Phoenix ICON wide-field infant fundus image:
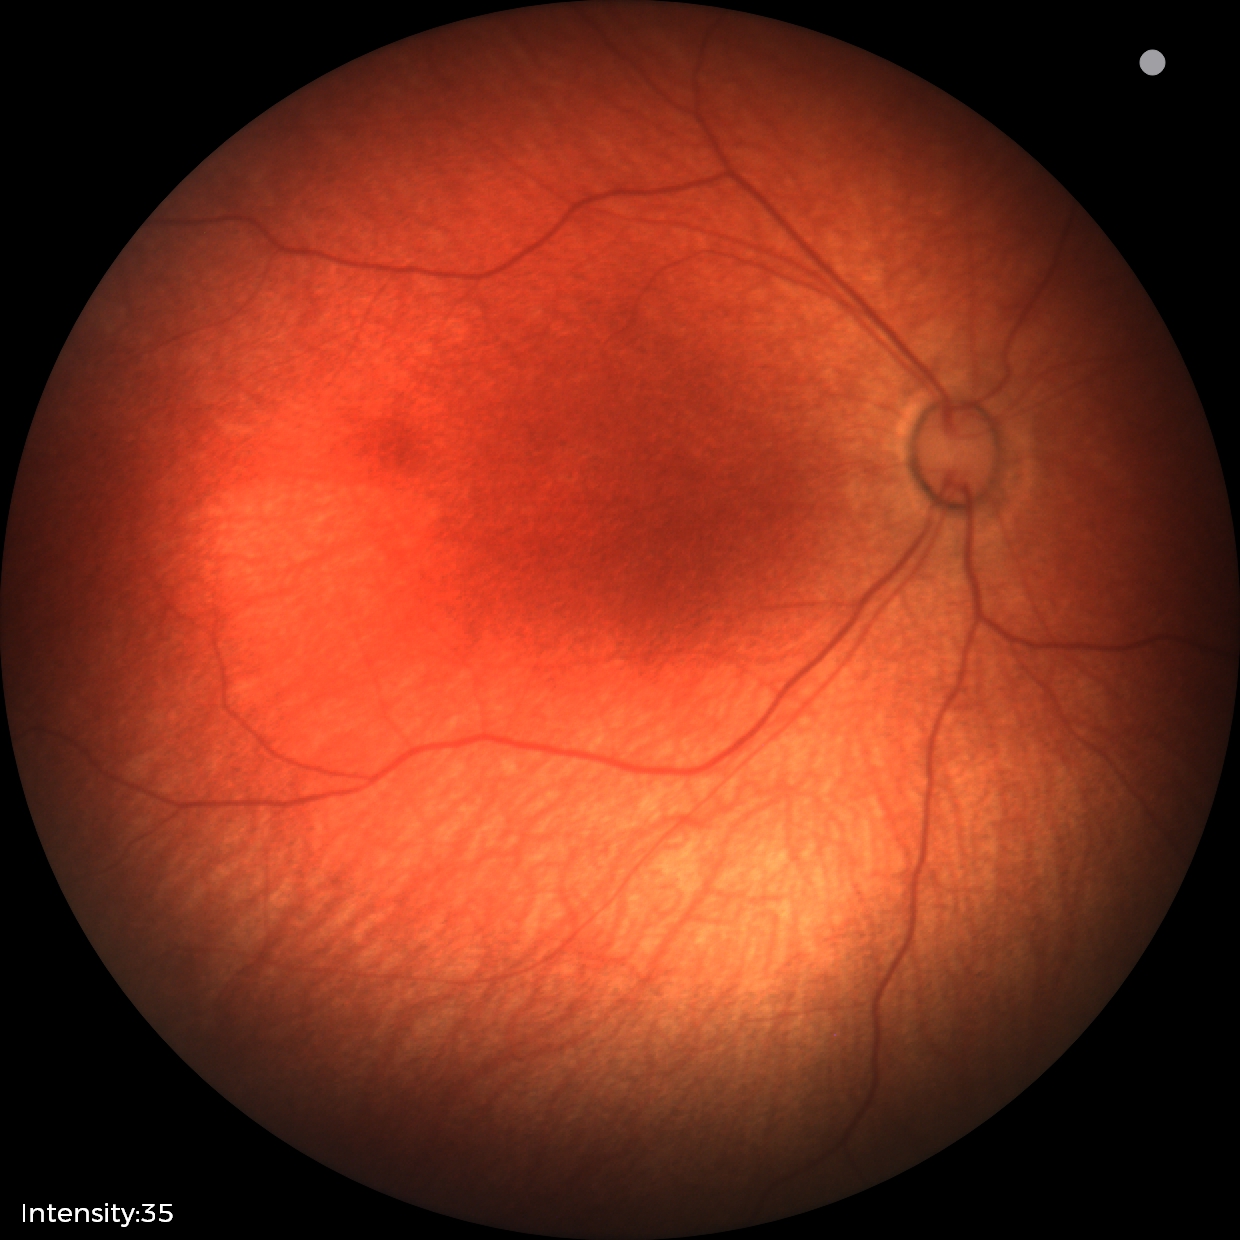
Screening examination diagnosed as physiological.